2352x1568px — 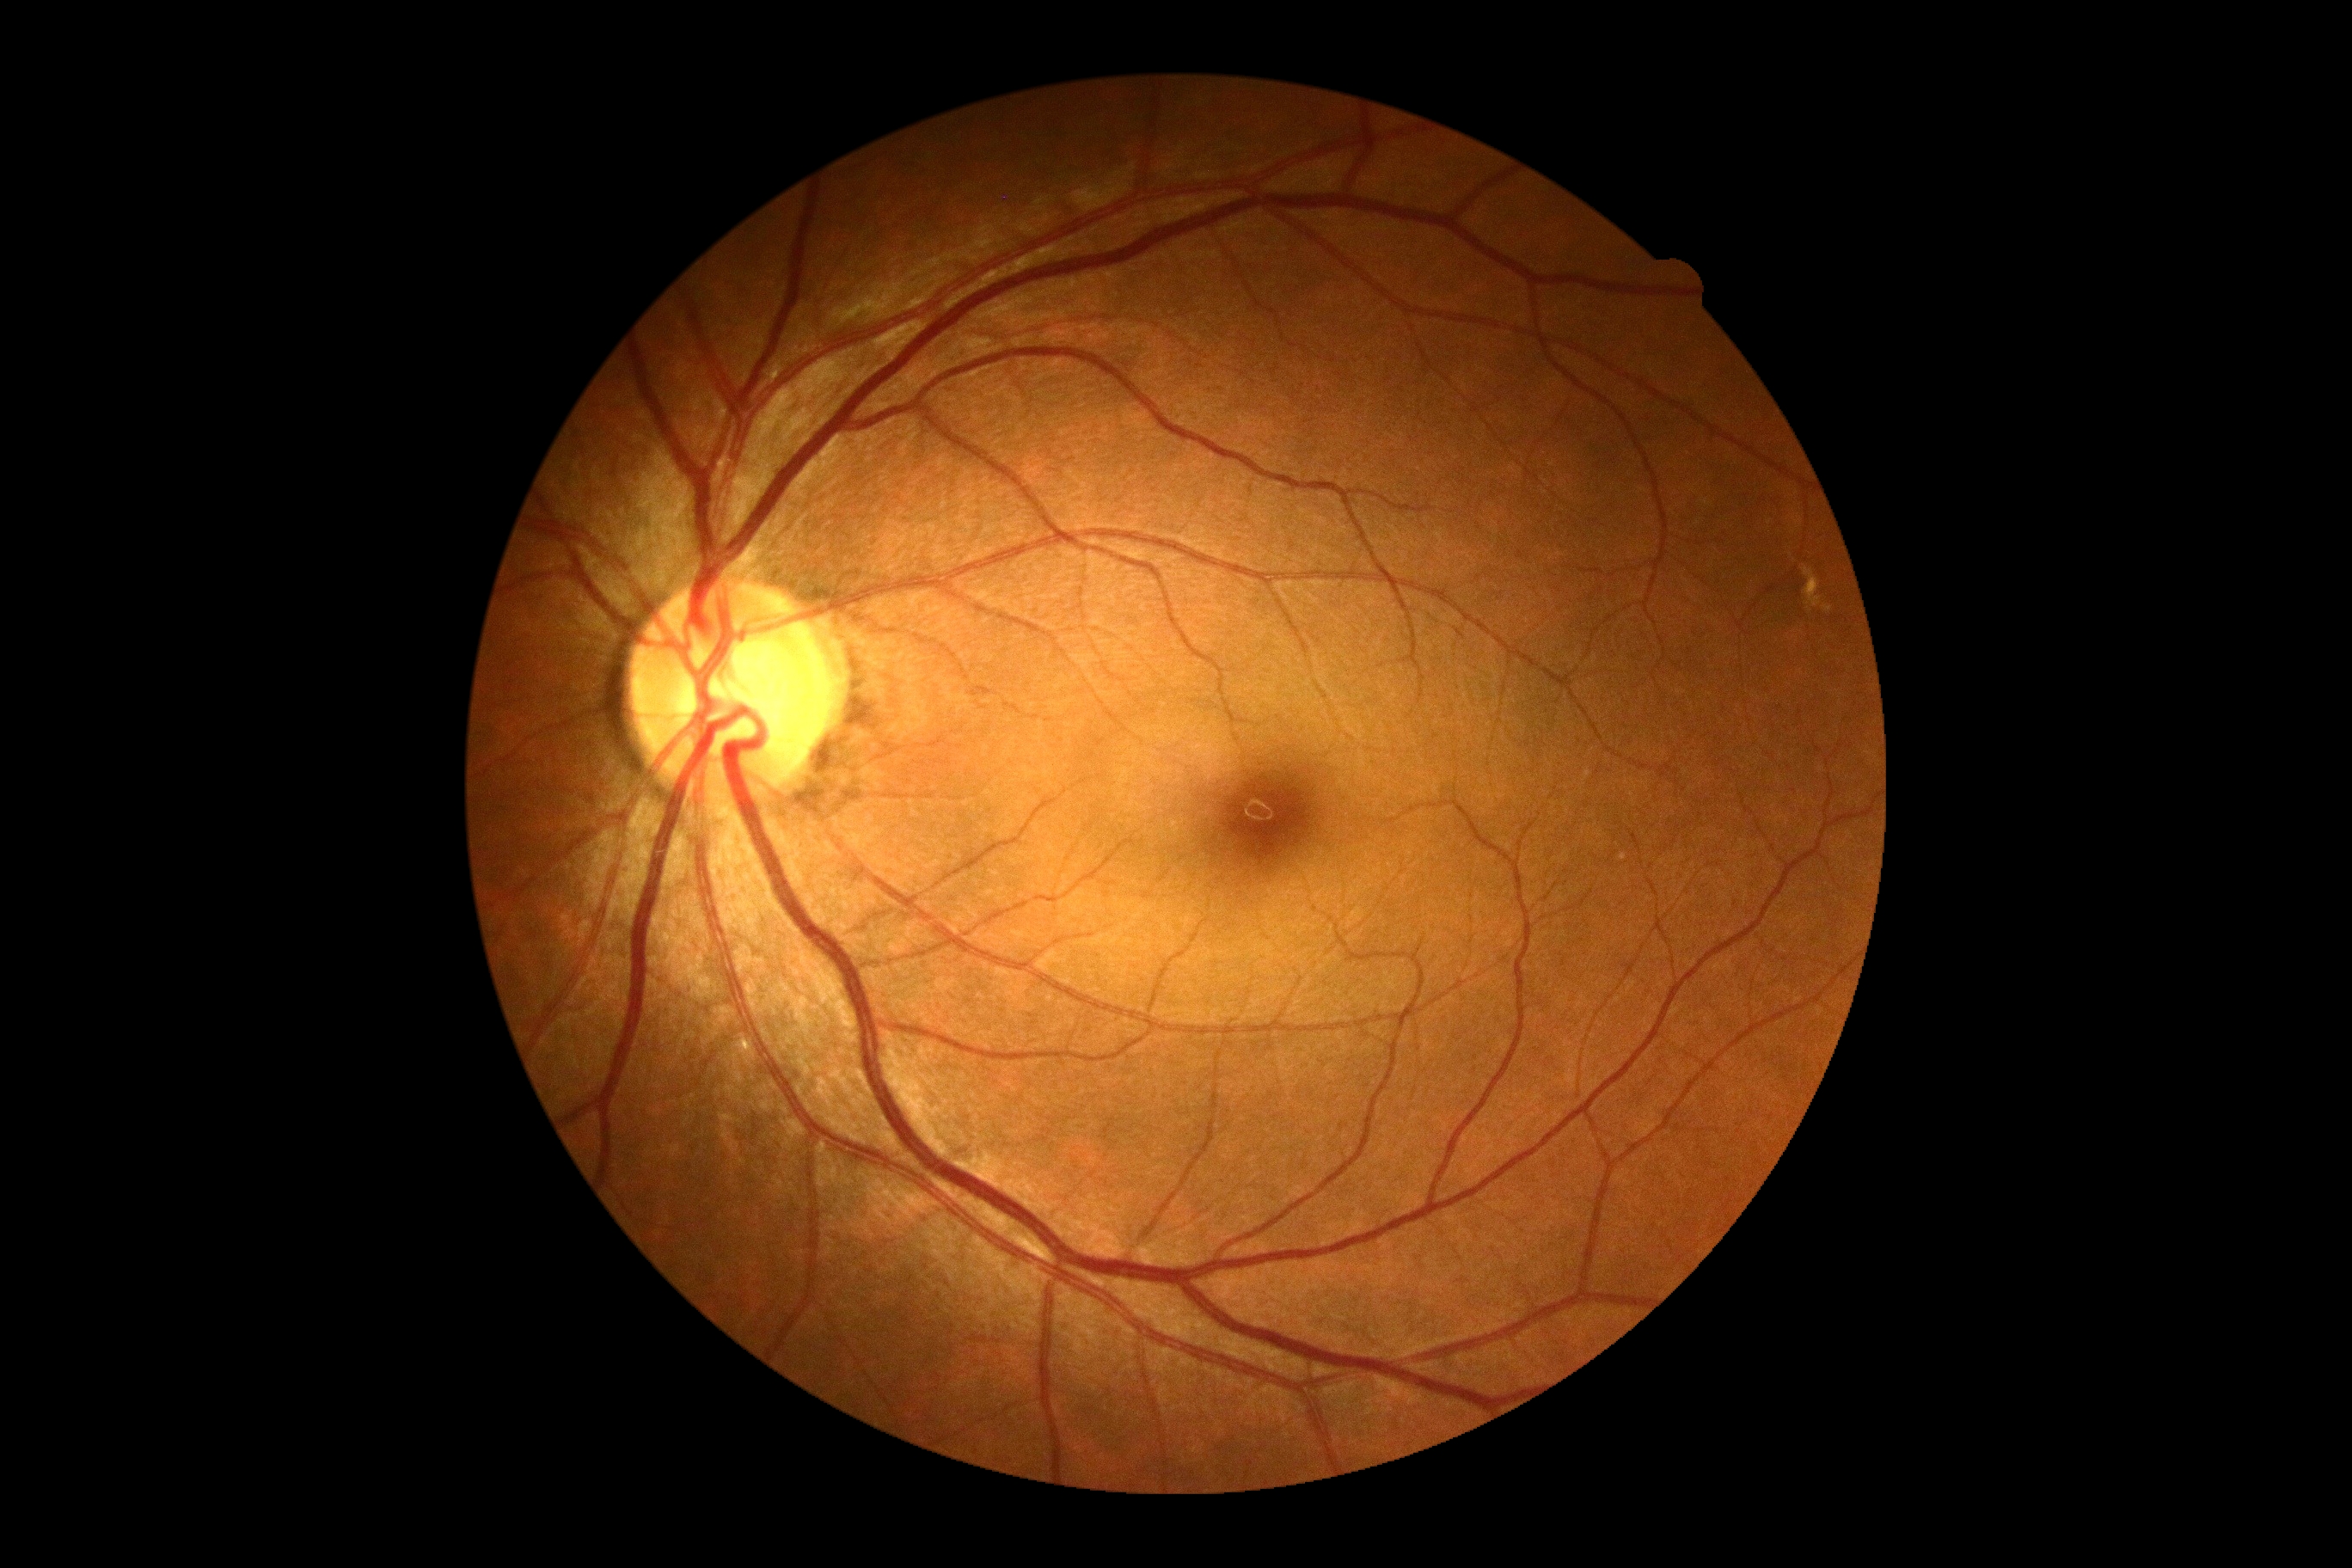

Diabetic retinopathy (DR): grade 0 (no apparent retinopathy) — no visible signs of diabetic retinopathy.